Retinal fundus photograph; image size 2352x1568; 45° FOV.
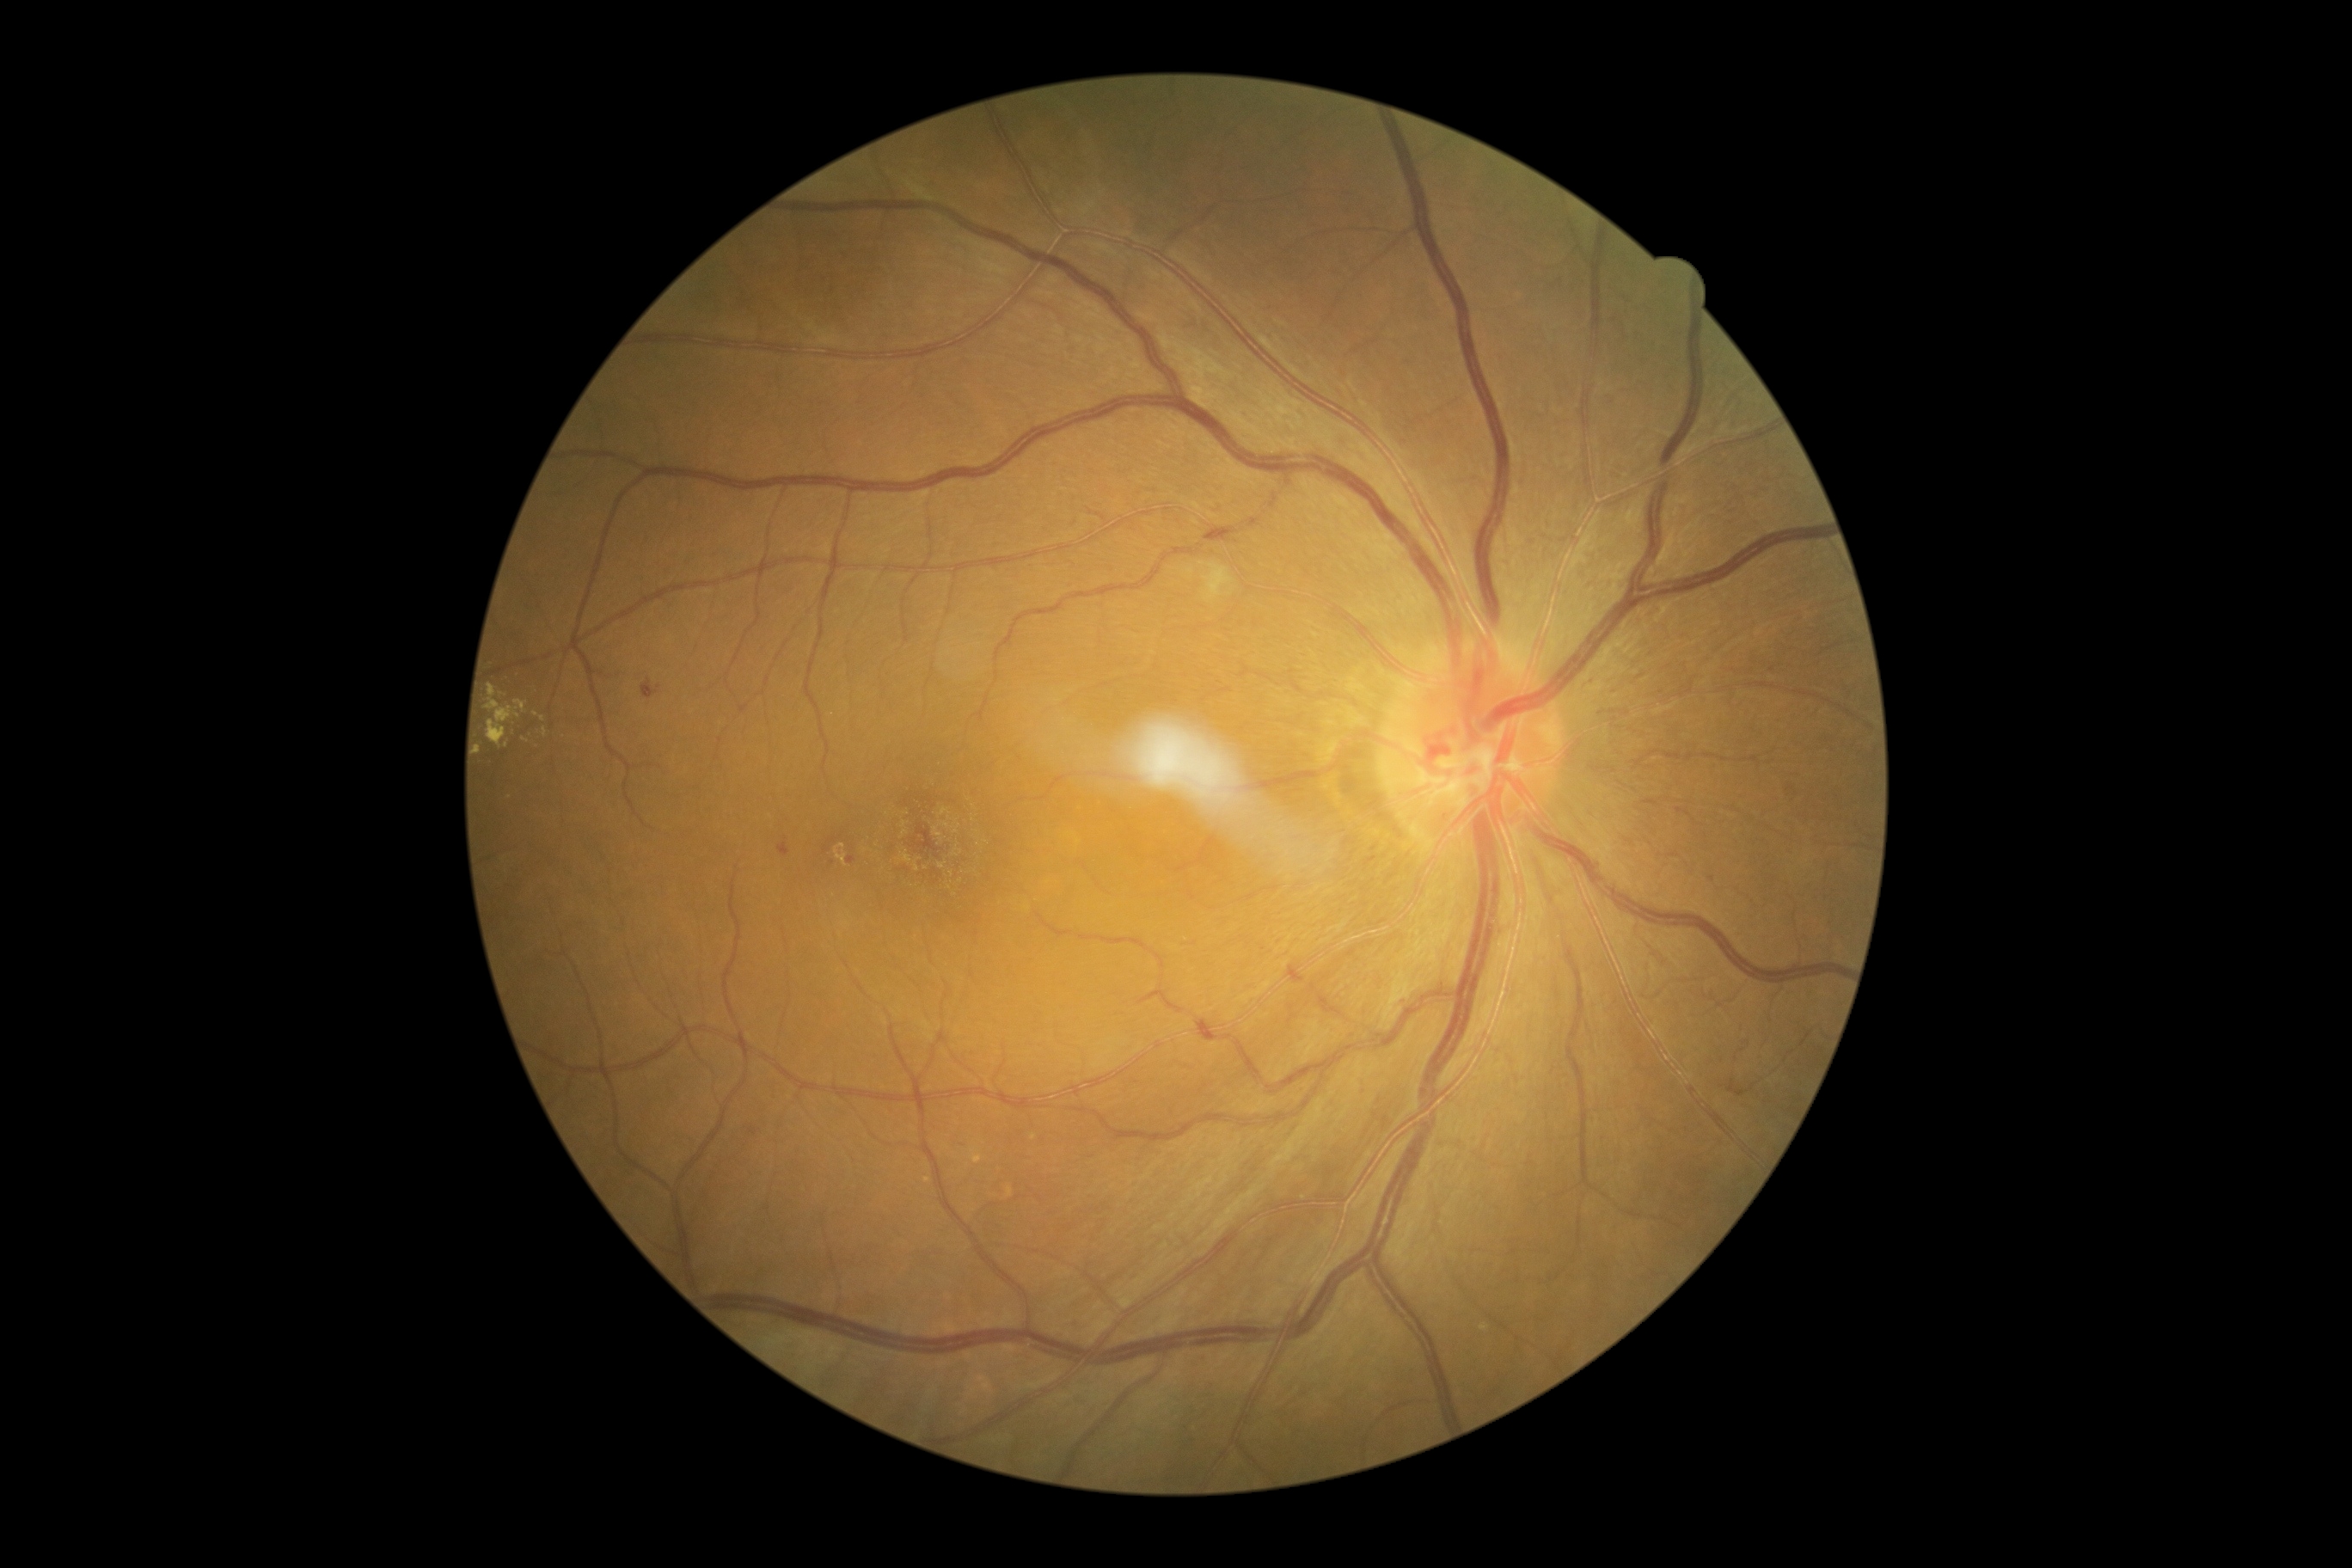
Diabetic retinopathy grade is moderate non-proliferative diabetic retinopathy (2).